45° FOV:
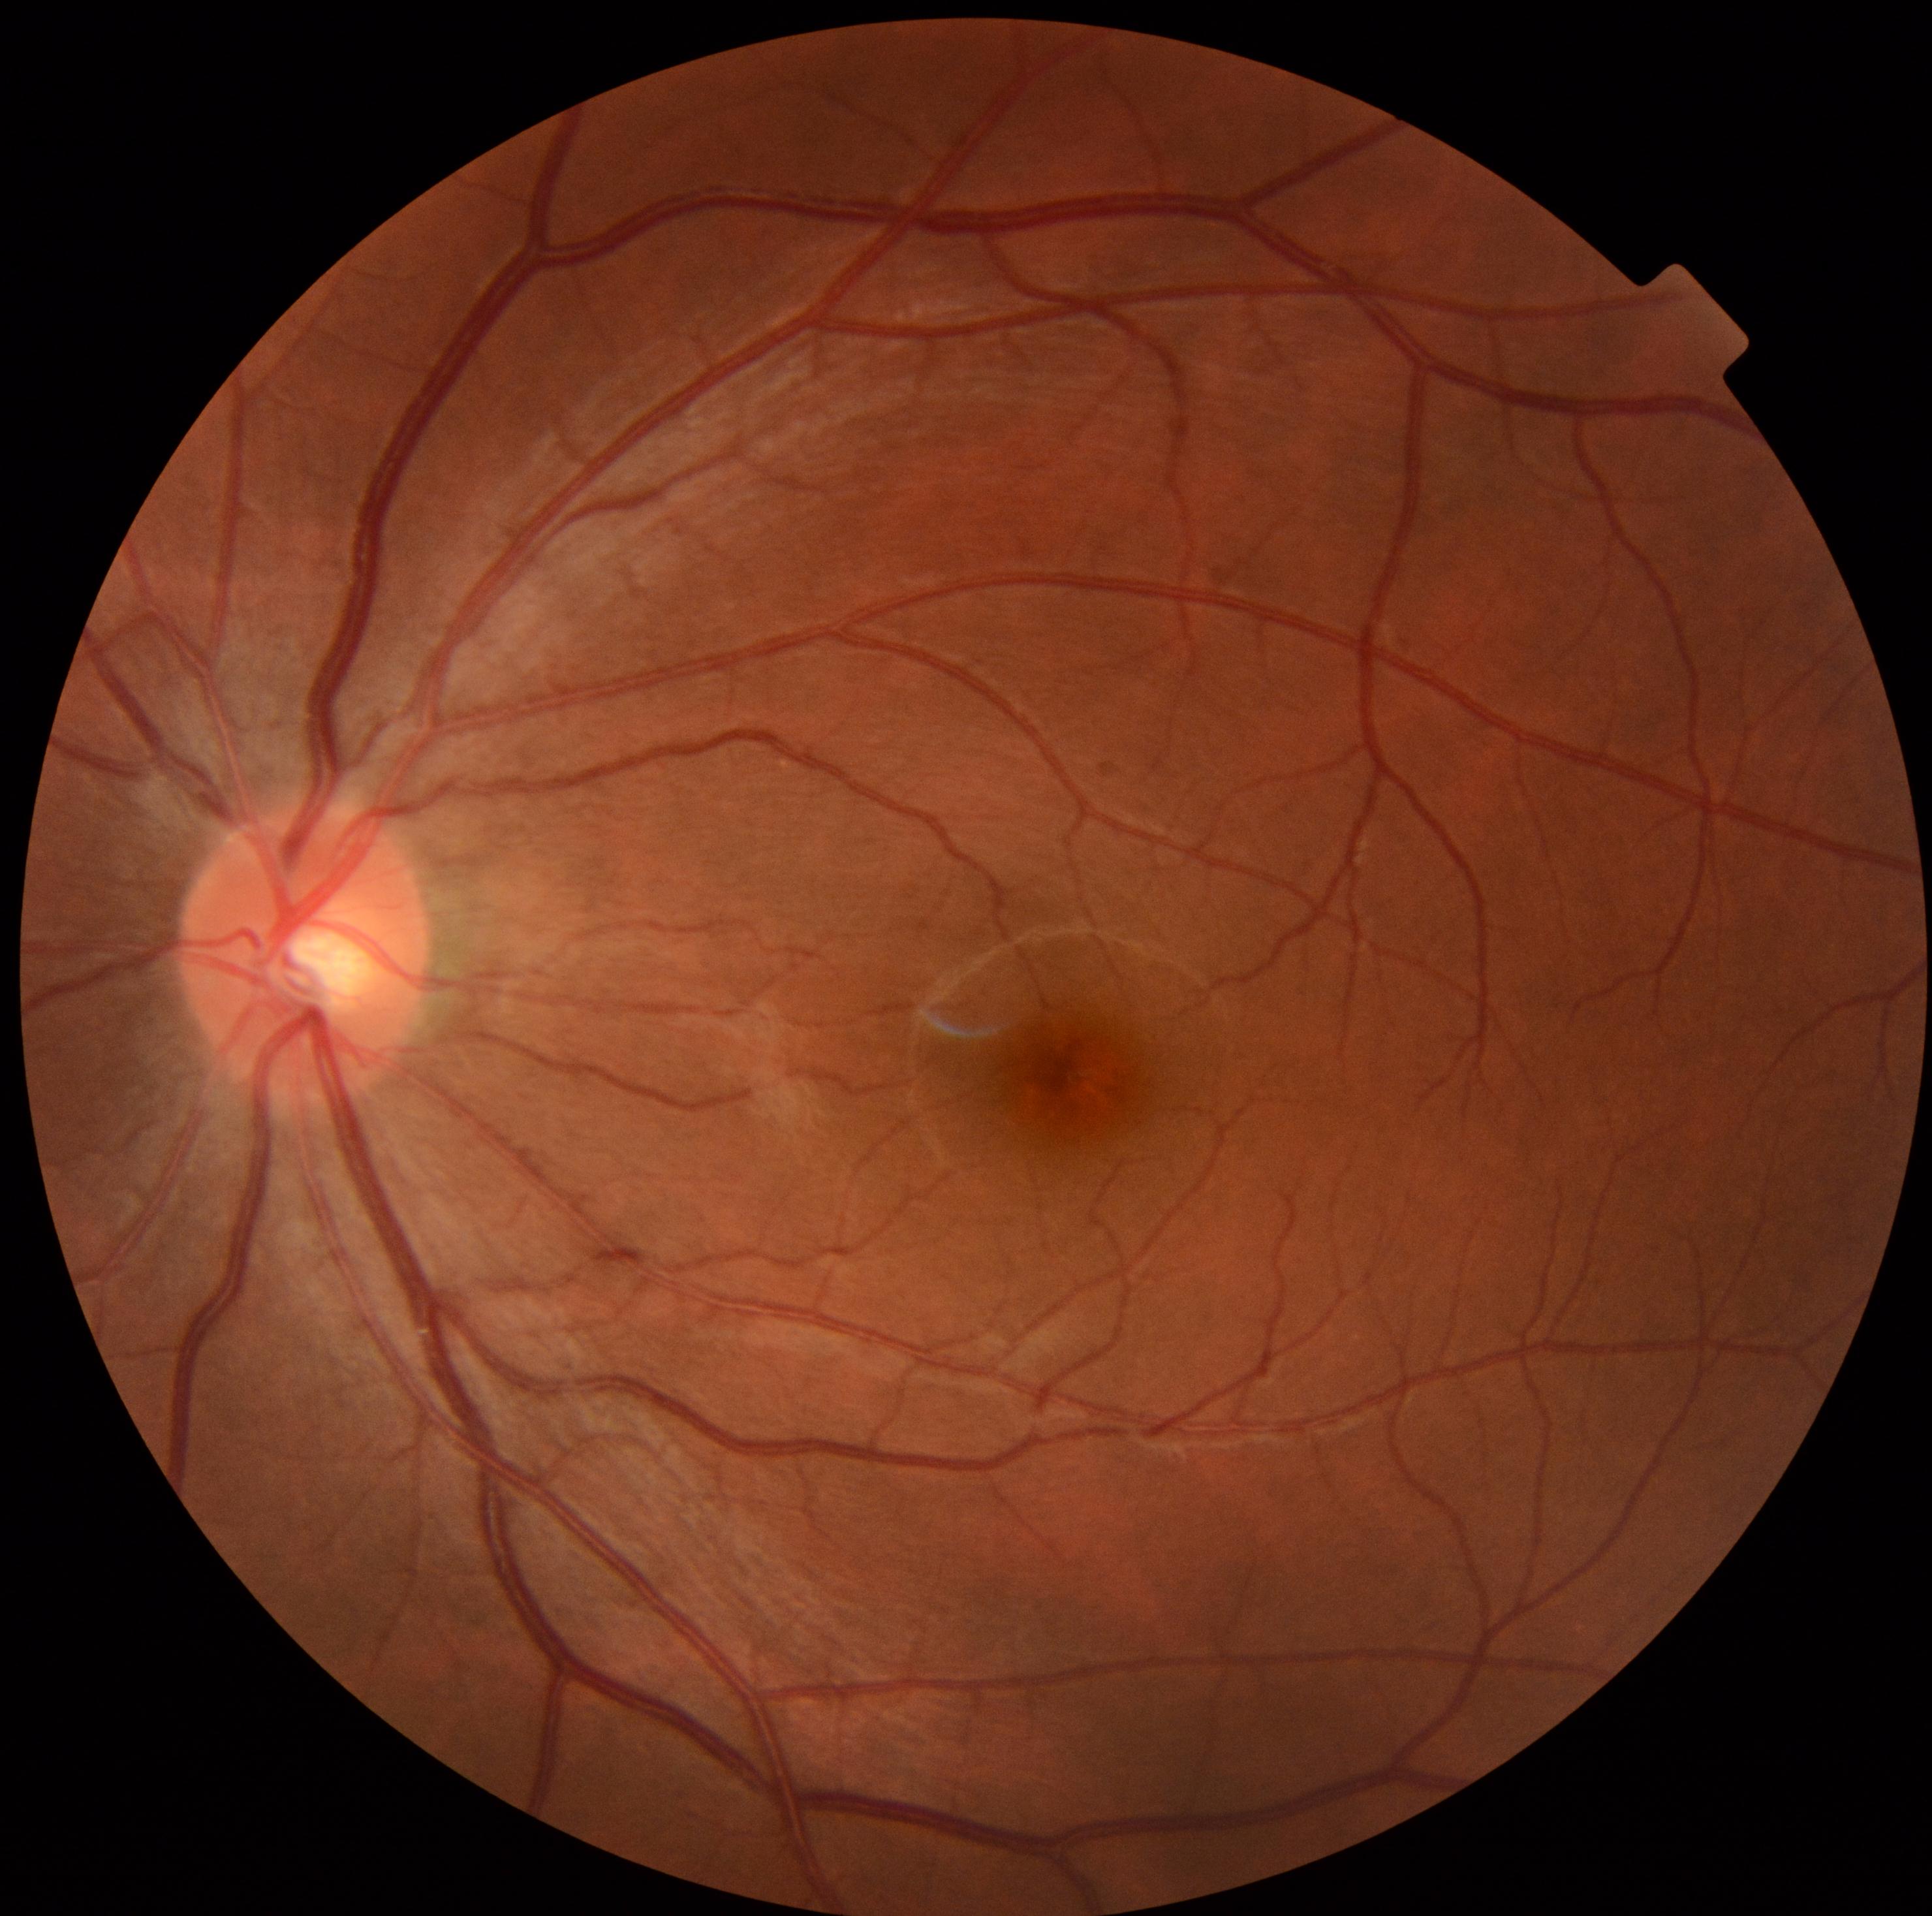

No signs of diabetic retinopathy.
Diabetic retinopathy: no apparent diabetic retinopathy (grade 0).